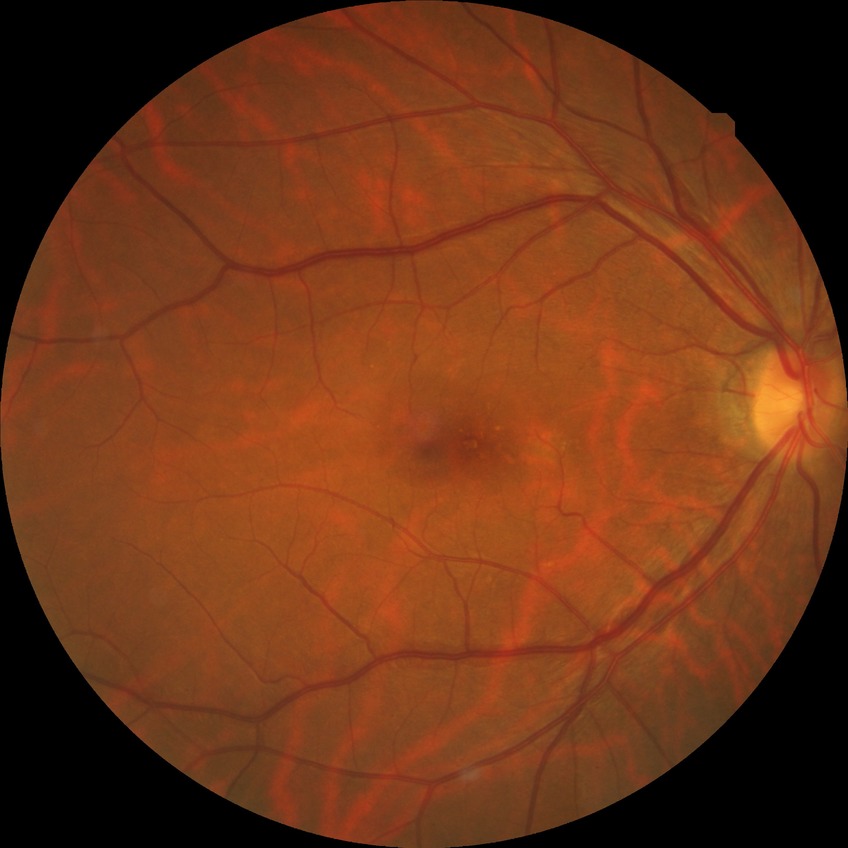 Modified Davis grading: no diabetic retinopathy.